Color fundus image.
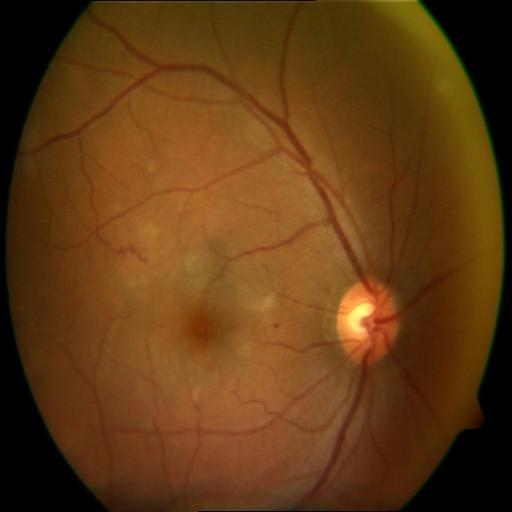

Two abnormalities. There is evidence of HR (hemorrhagic retinopathy) & CME (cystoid macular edema).